Graded on the modified Davis scale — 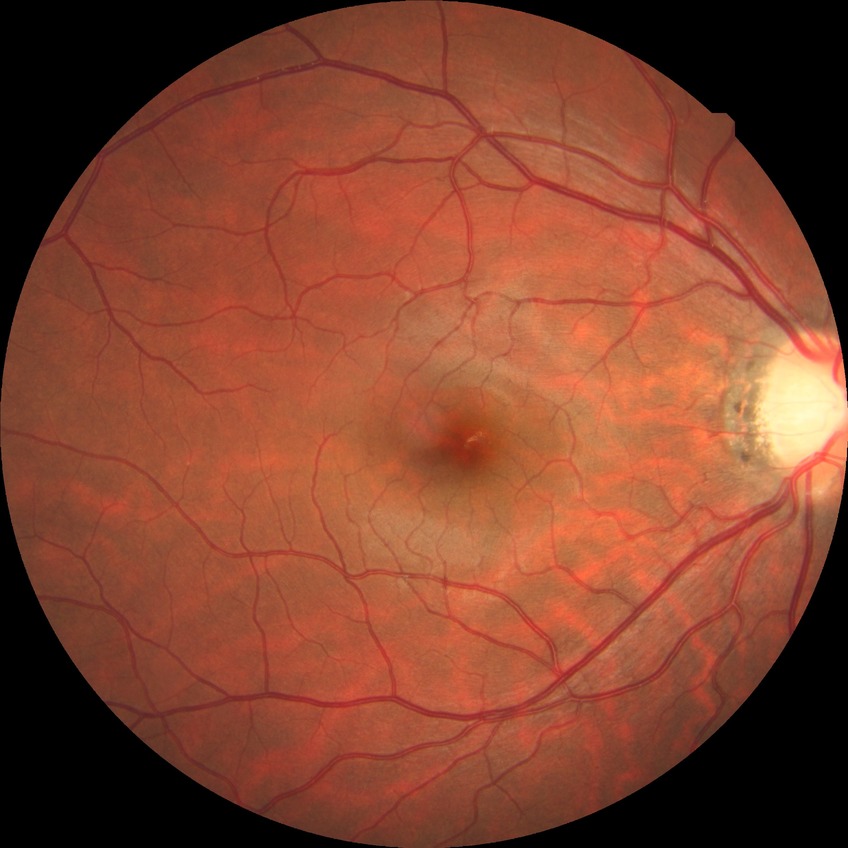 Findings:
• DR stage — NDR